45° field of view. Image size 2184x1682. CFP:
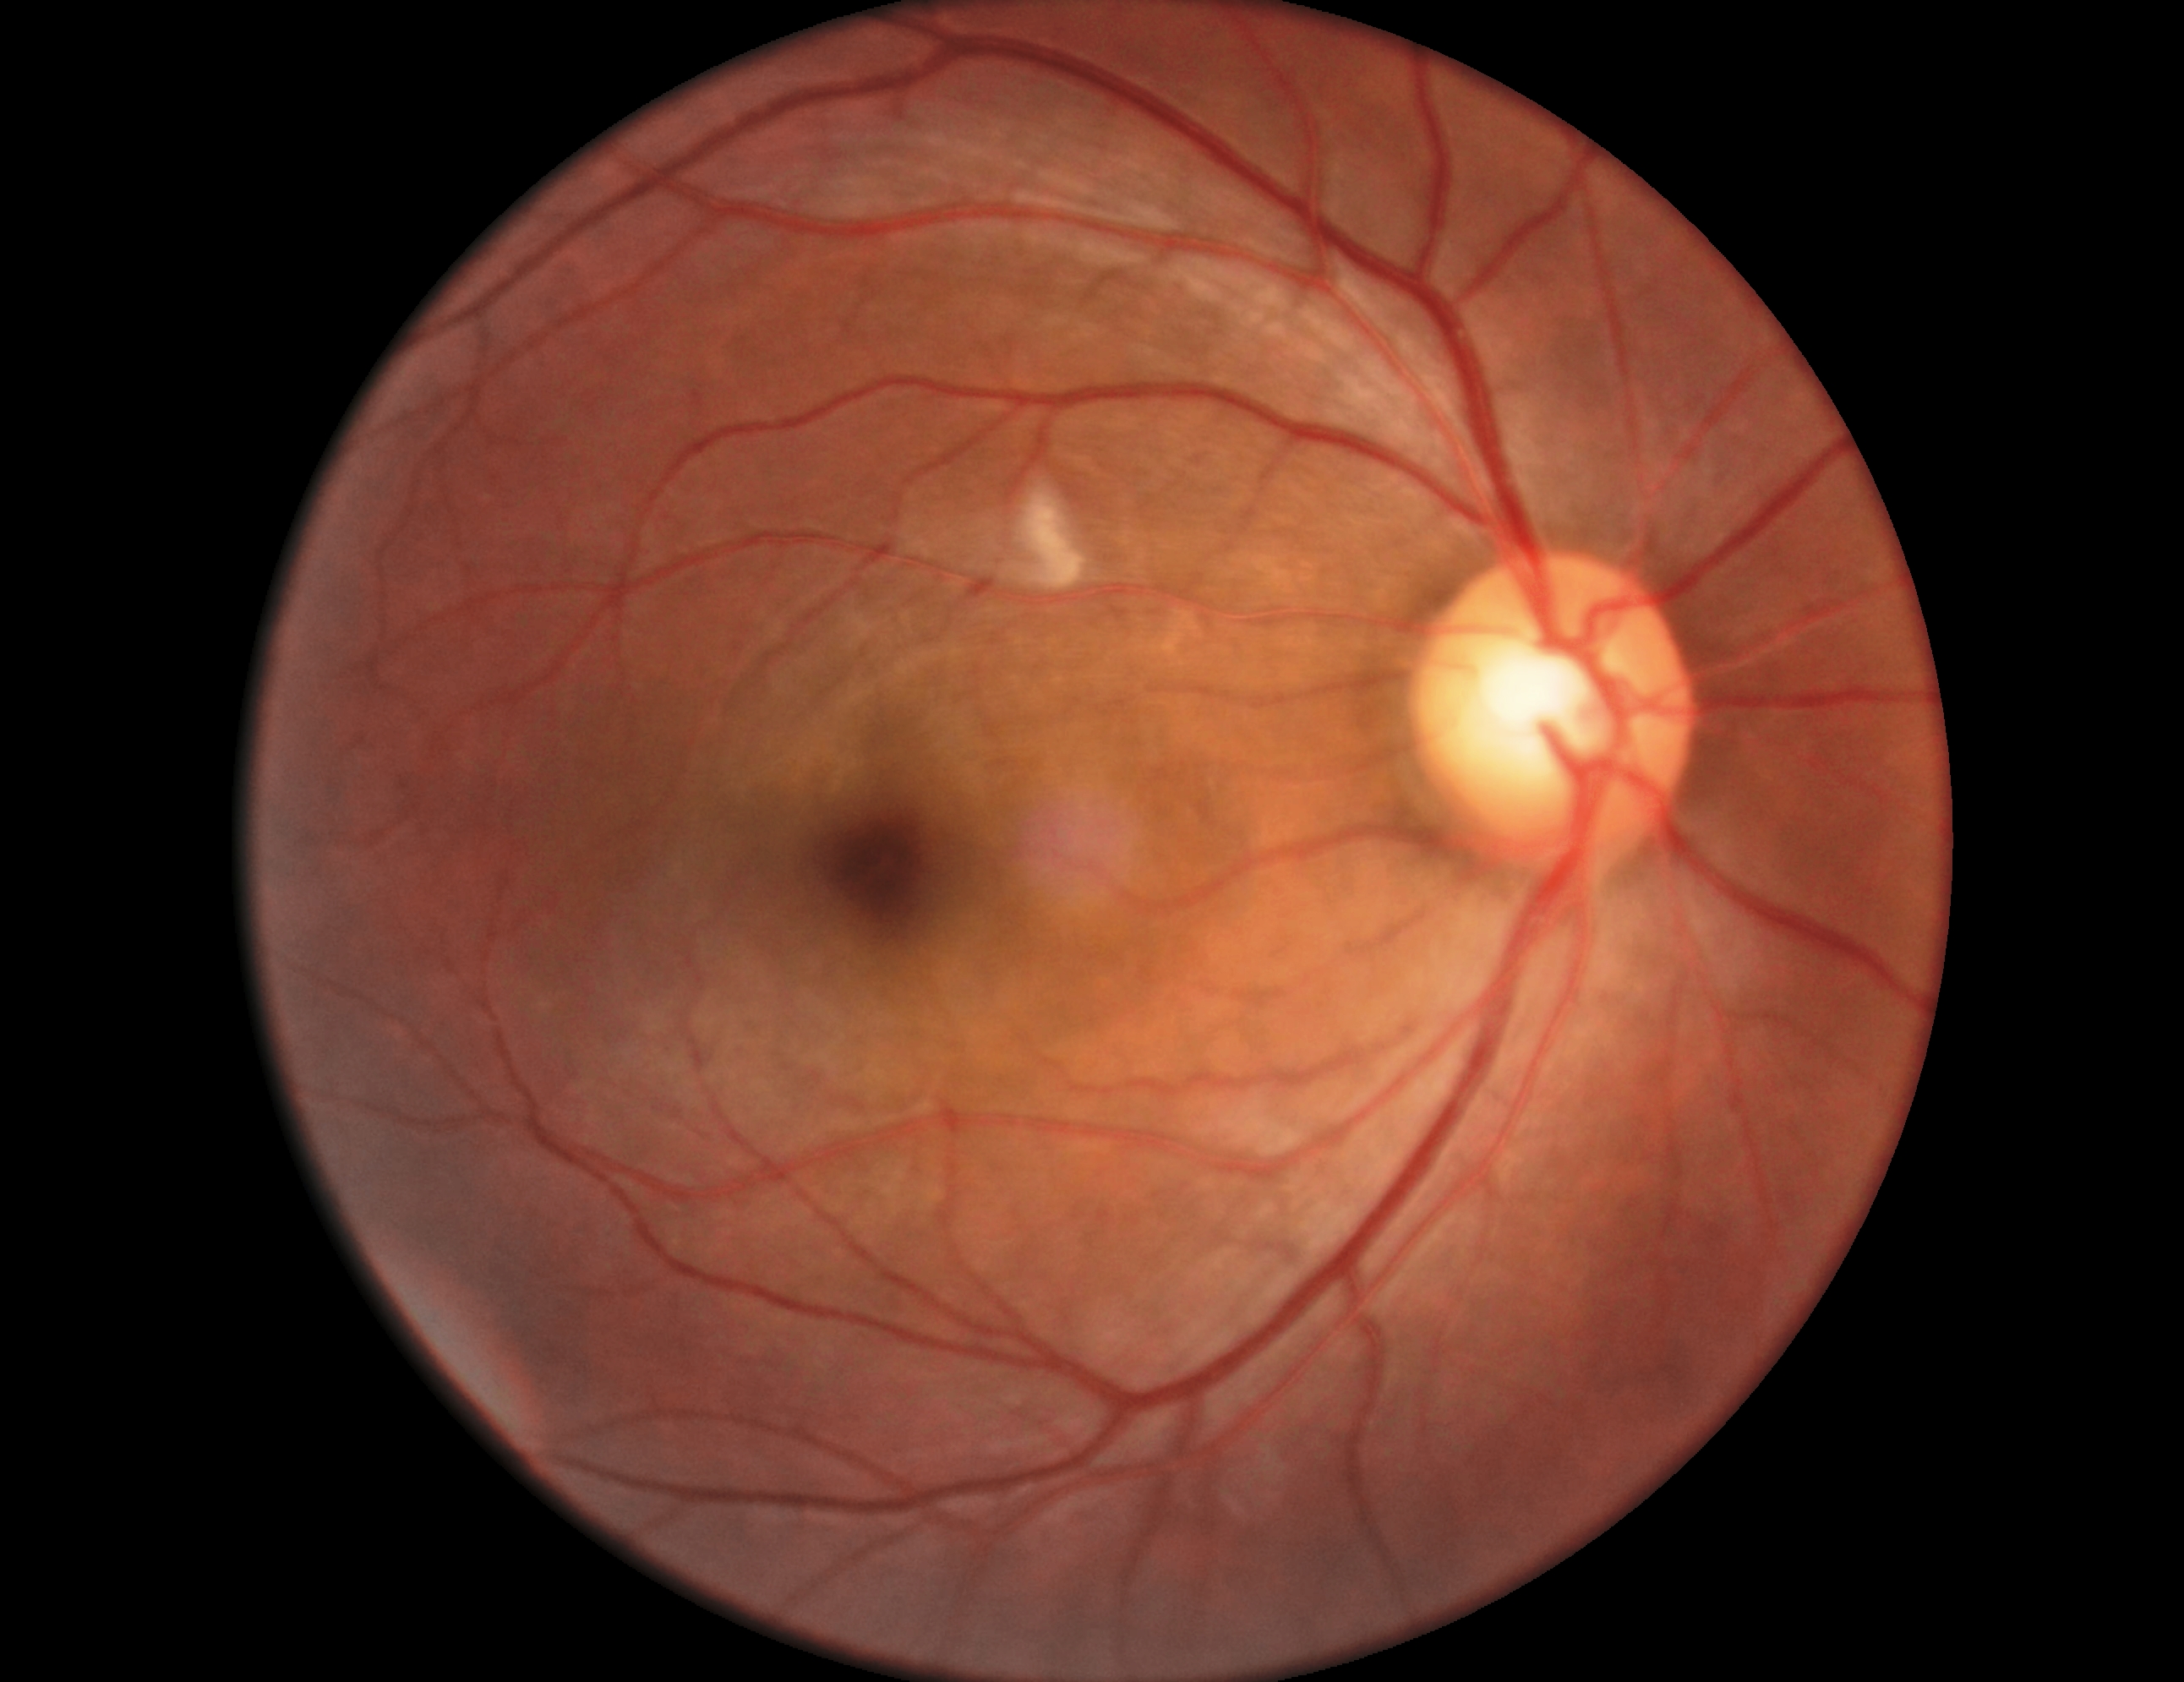

diabetic retinopathy grade = 2 (moderate NPDR).